NIDEK AFC-230 fundus camera; color fundus photograph; modified Davis classification:
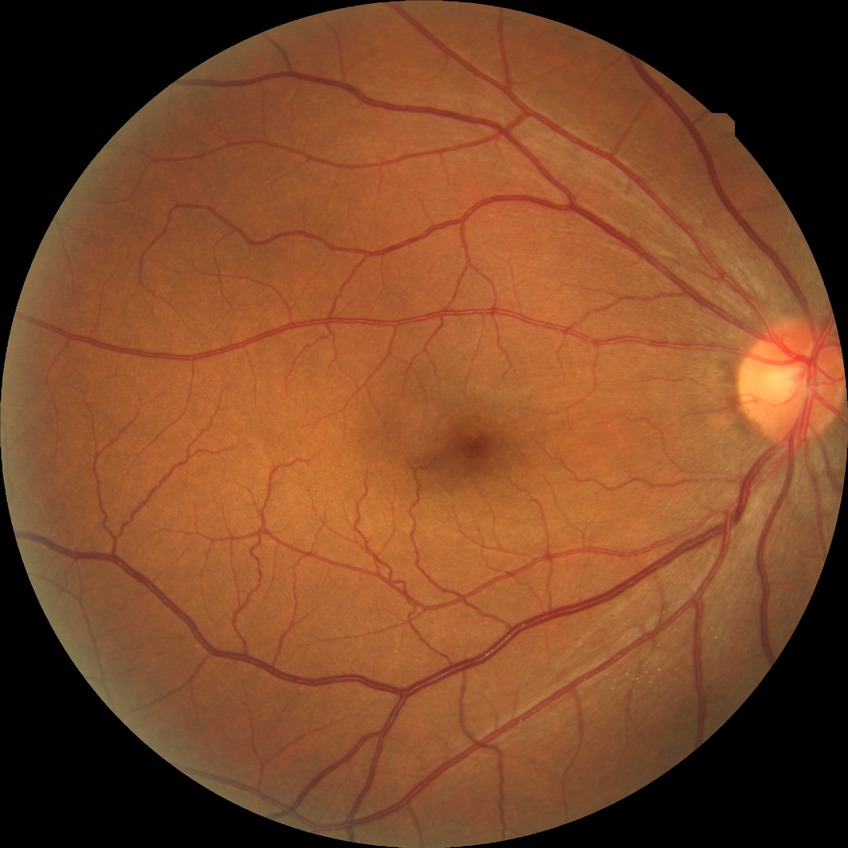

Retinopathy grade is no diabetic retinopathy.